2228x1652 · color fundus image
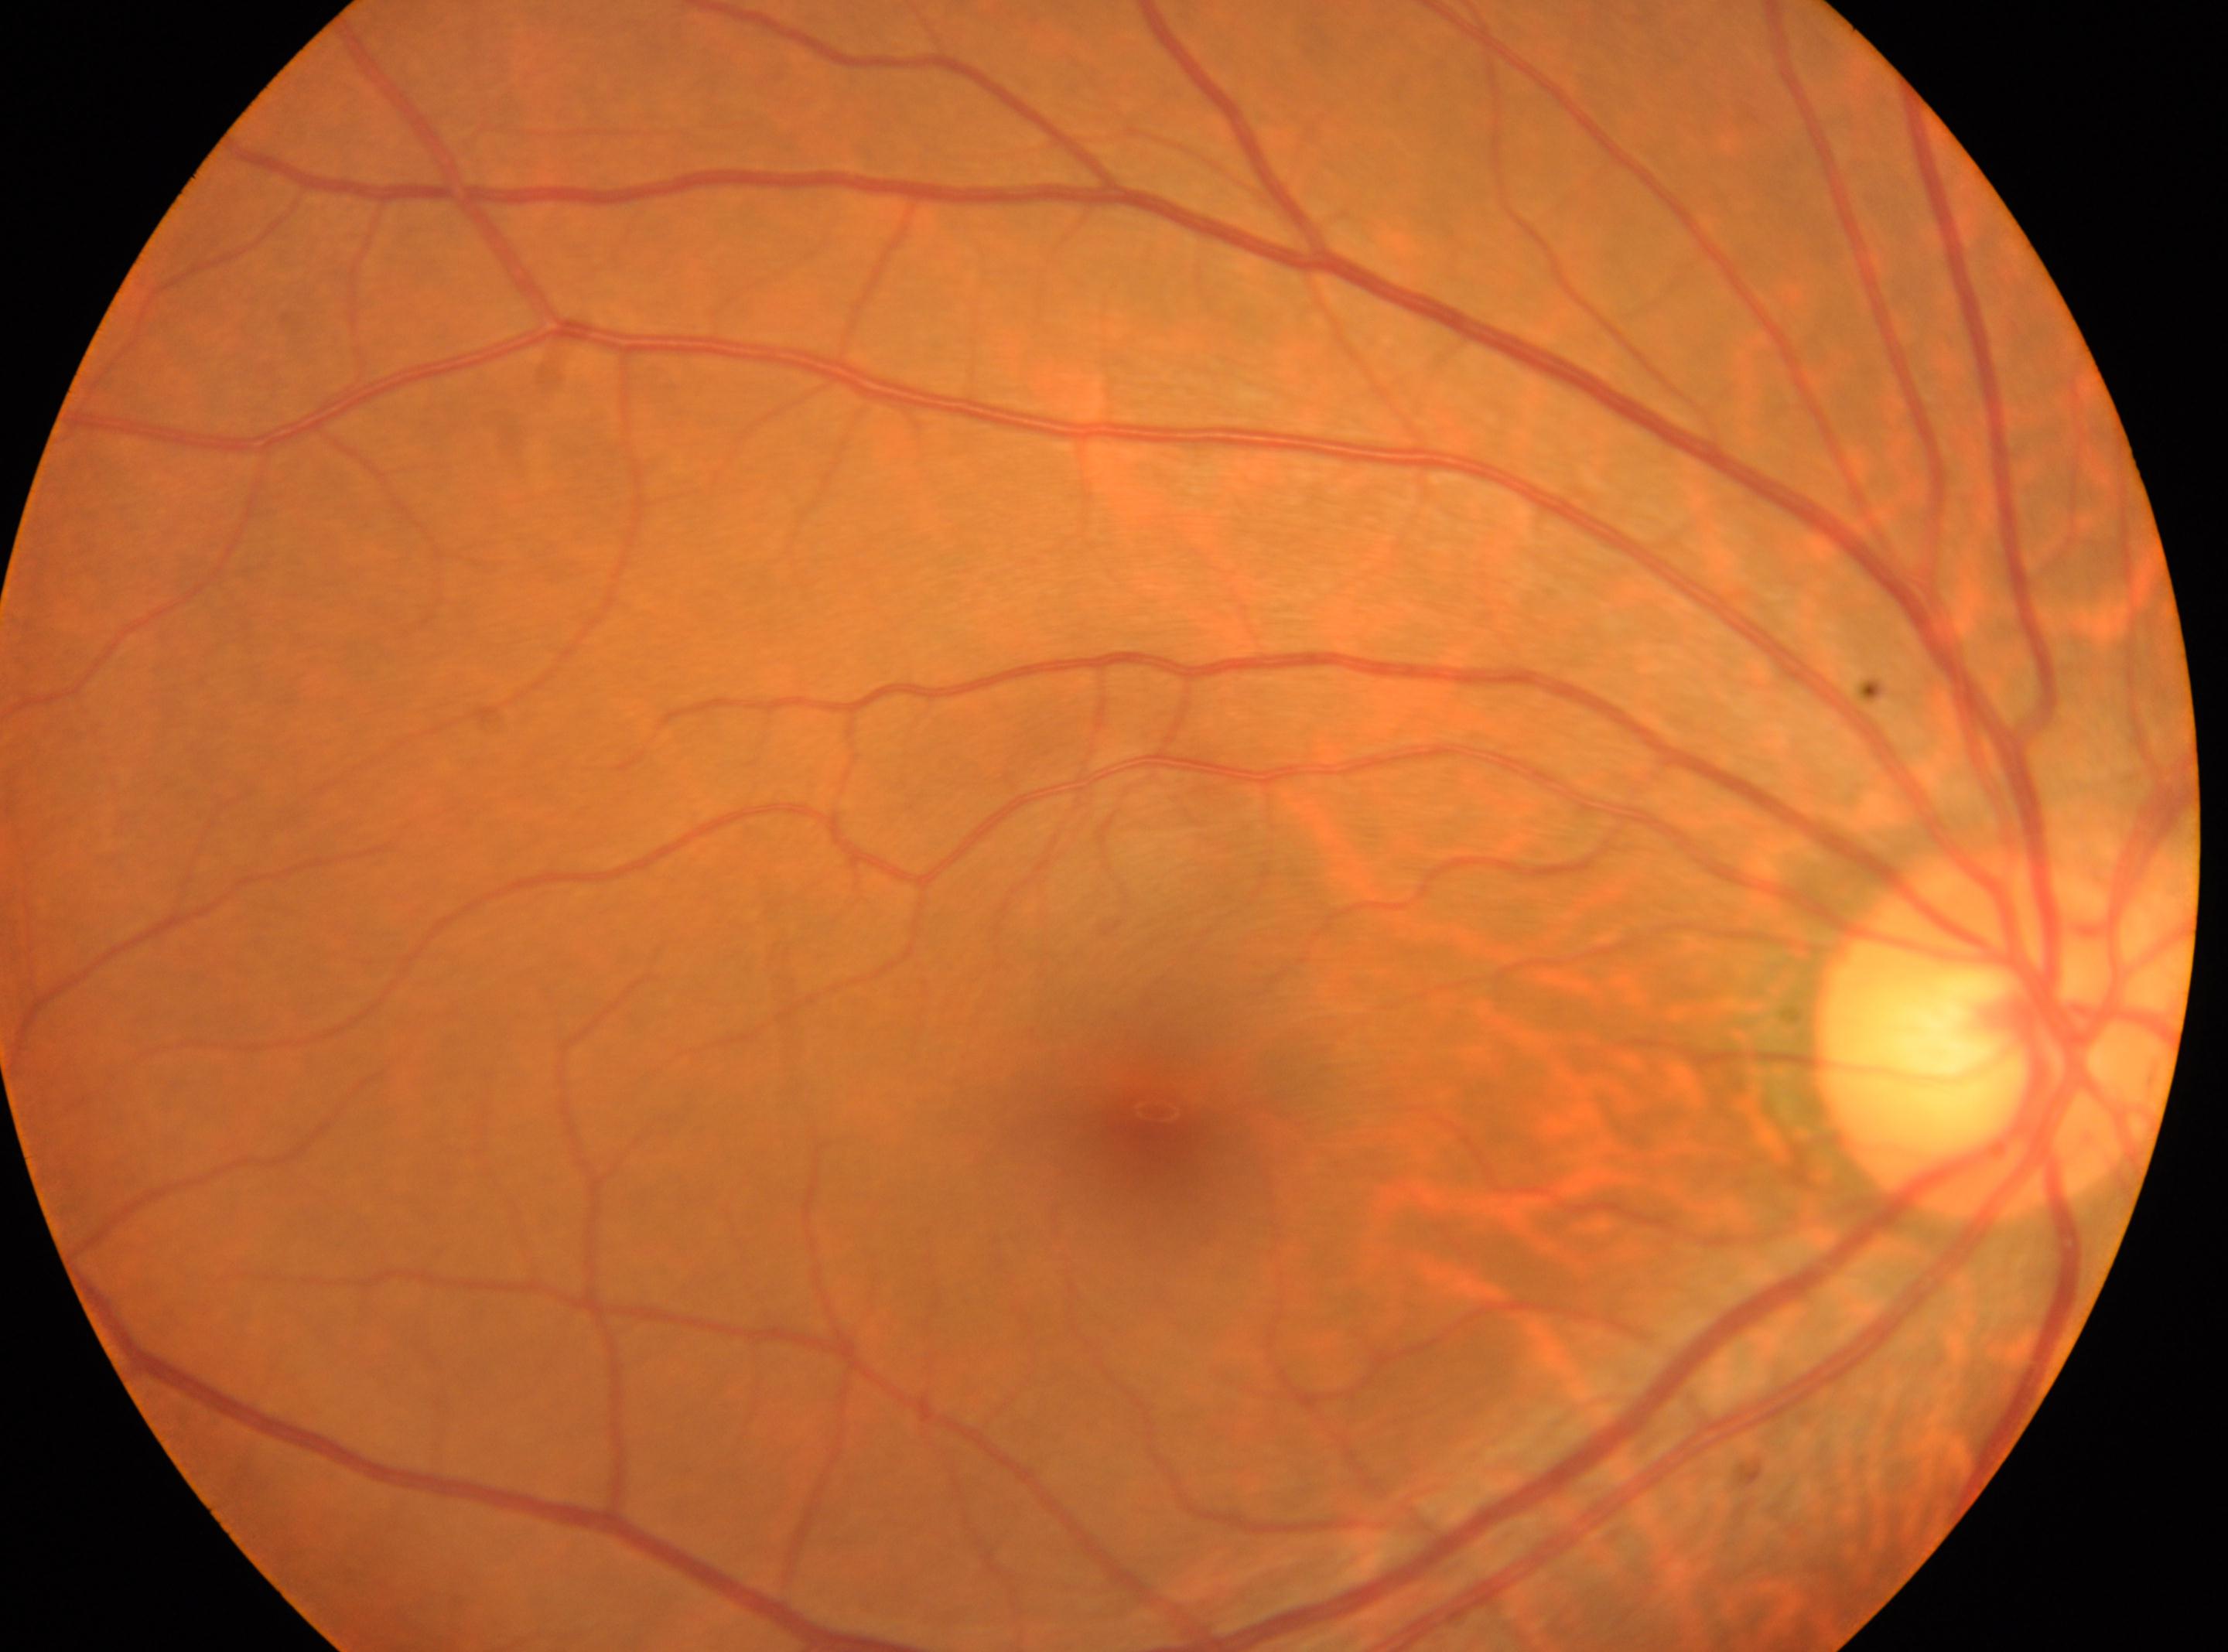

fovea centralis = (x=1156, y=1132) | diabetic retinopathy (DR) = grade 0 | the optic disc = (x=1998, y=1029) | eye = OD.